Camera: NIDEK AFC-230, FOV: 45 degrees, posterior pole photograph, 848 by 848 pixels
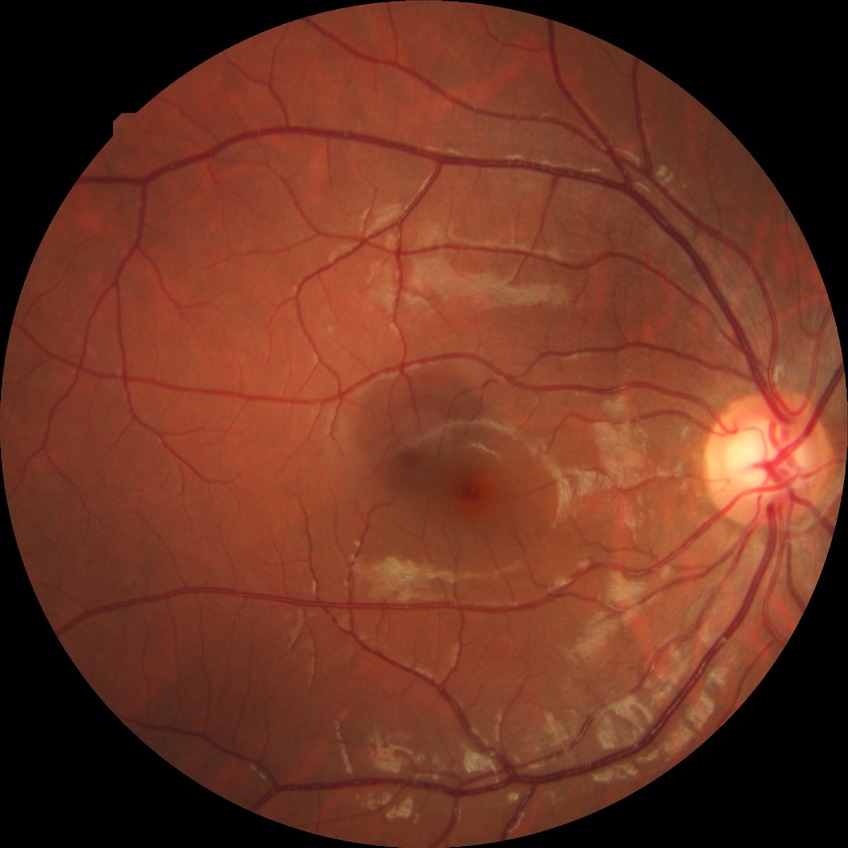
Davis DR grade is NDR.